CFP
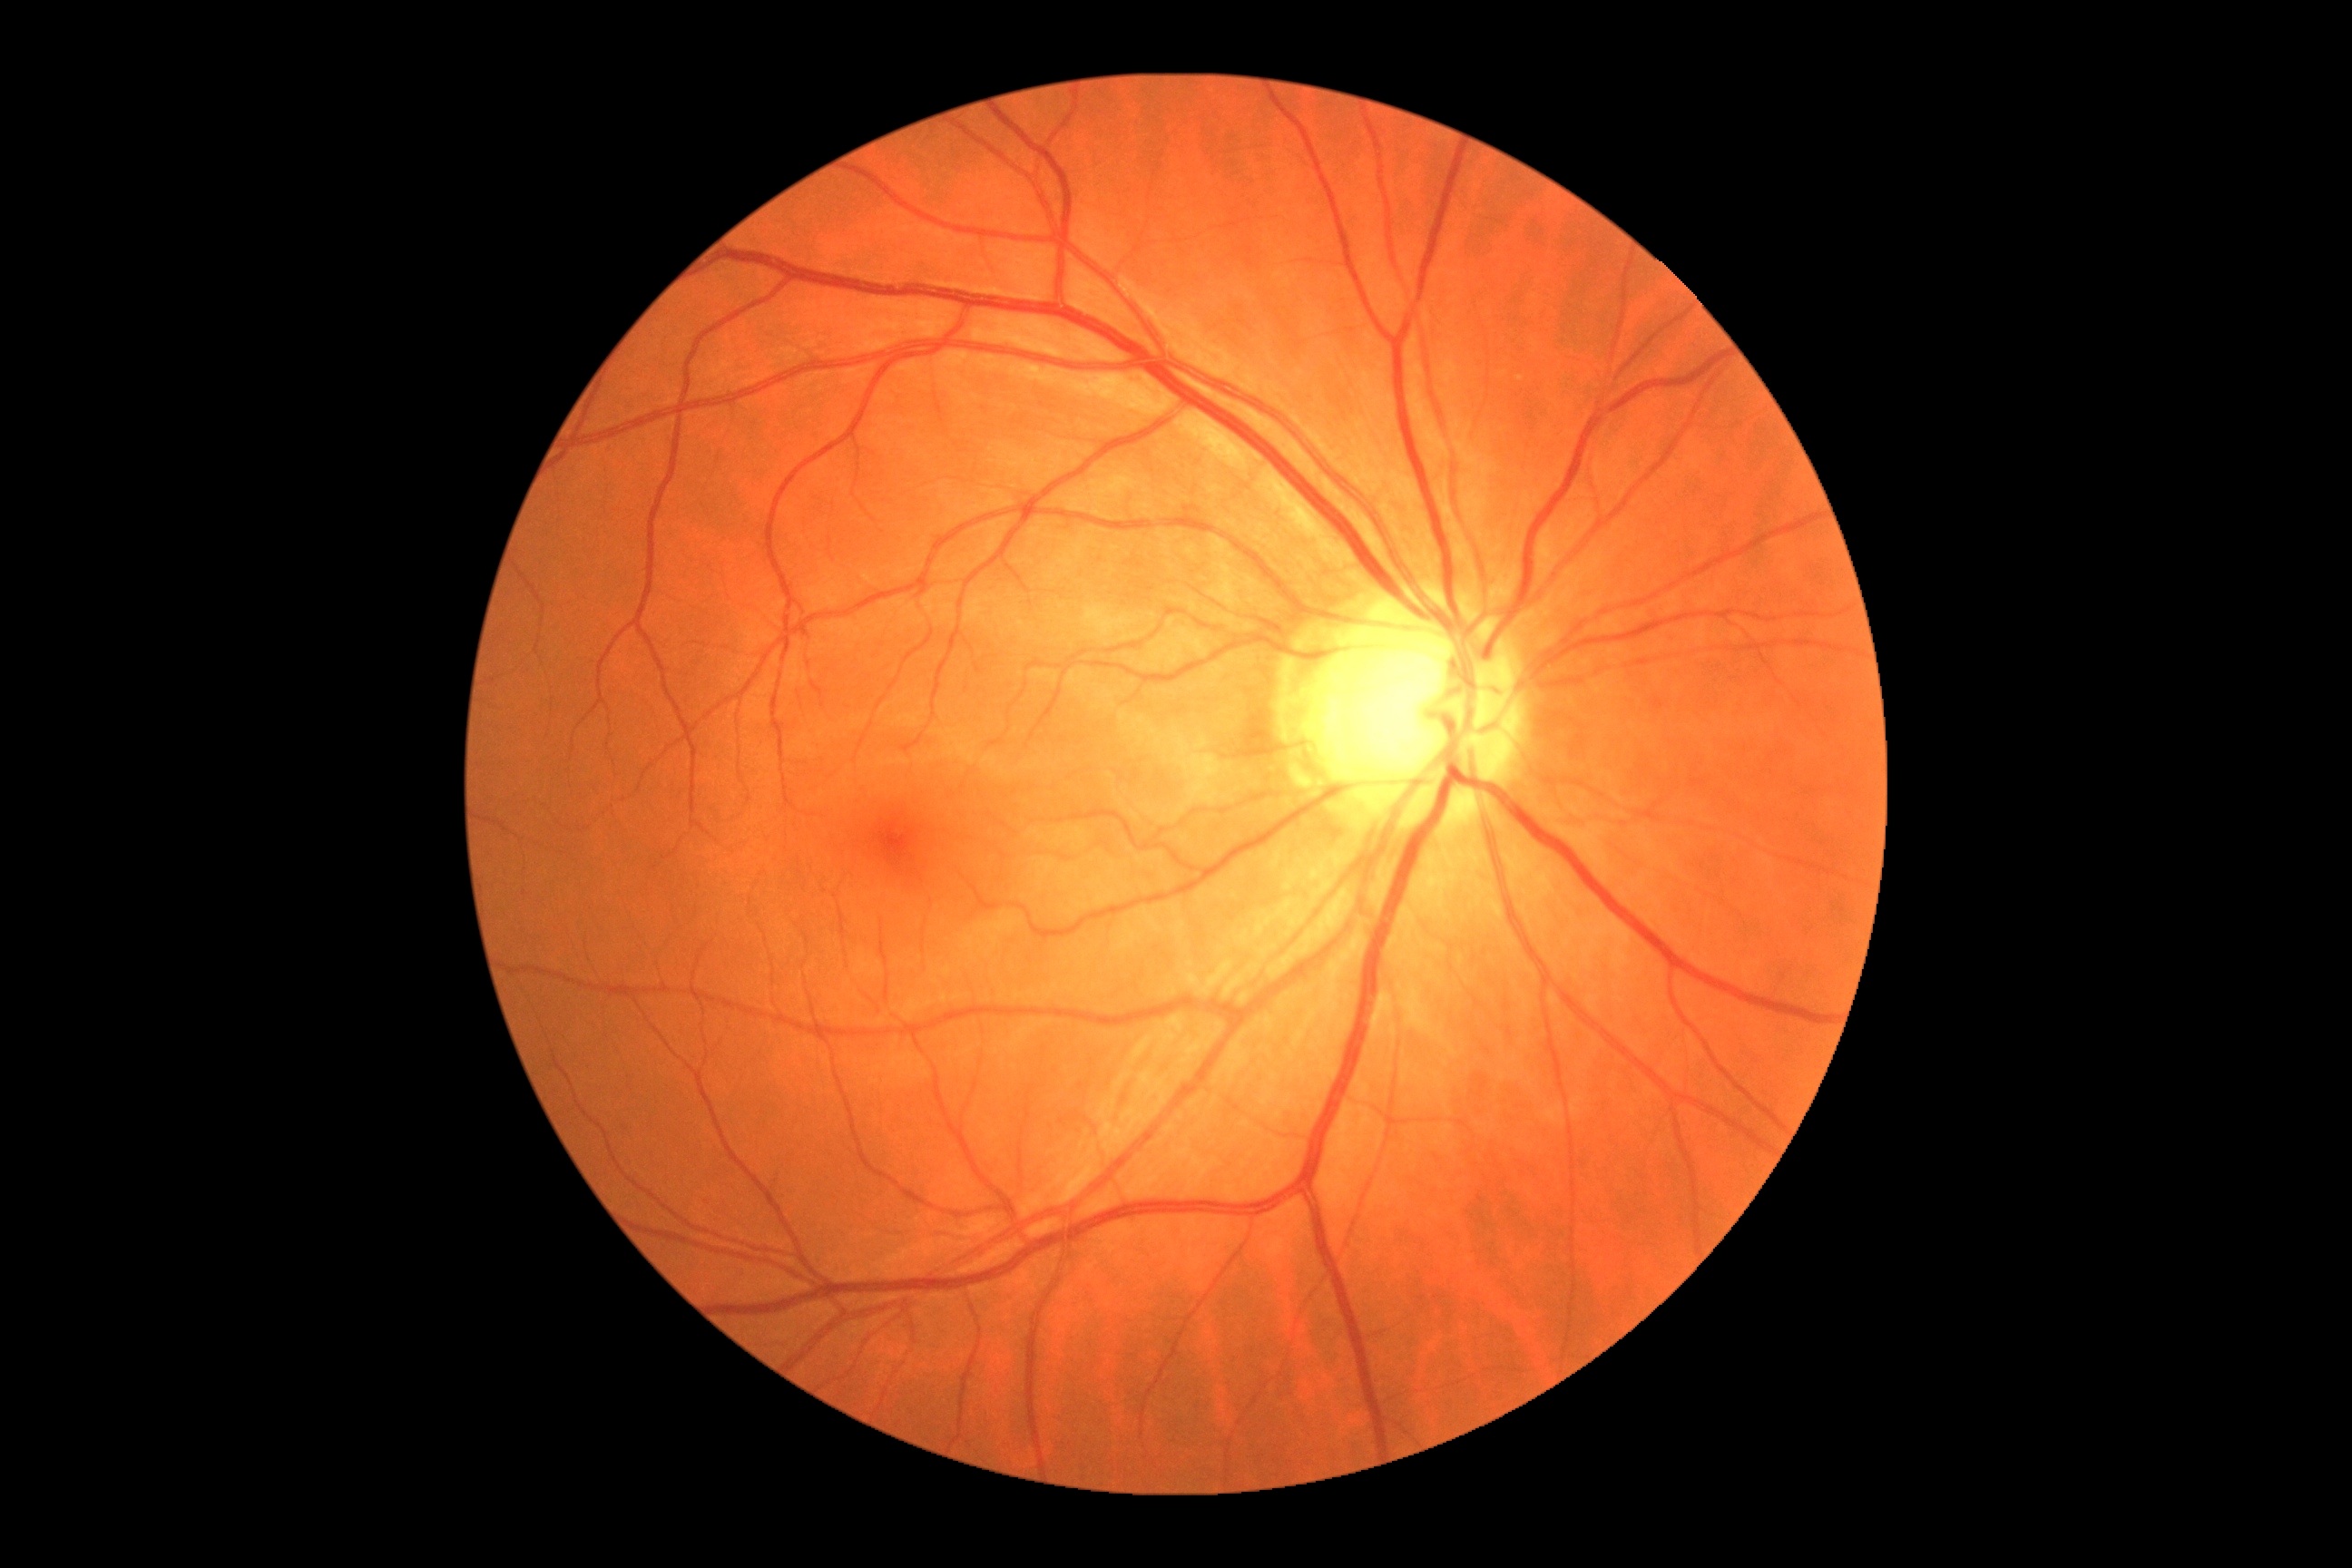

DR stage is no apparent retinopathy (grade 0).